UWF retinal mosaic. FOV: 200 degrees — 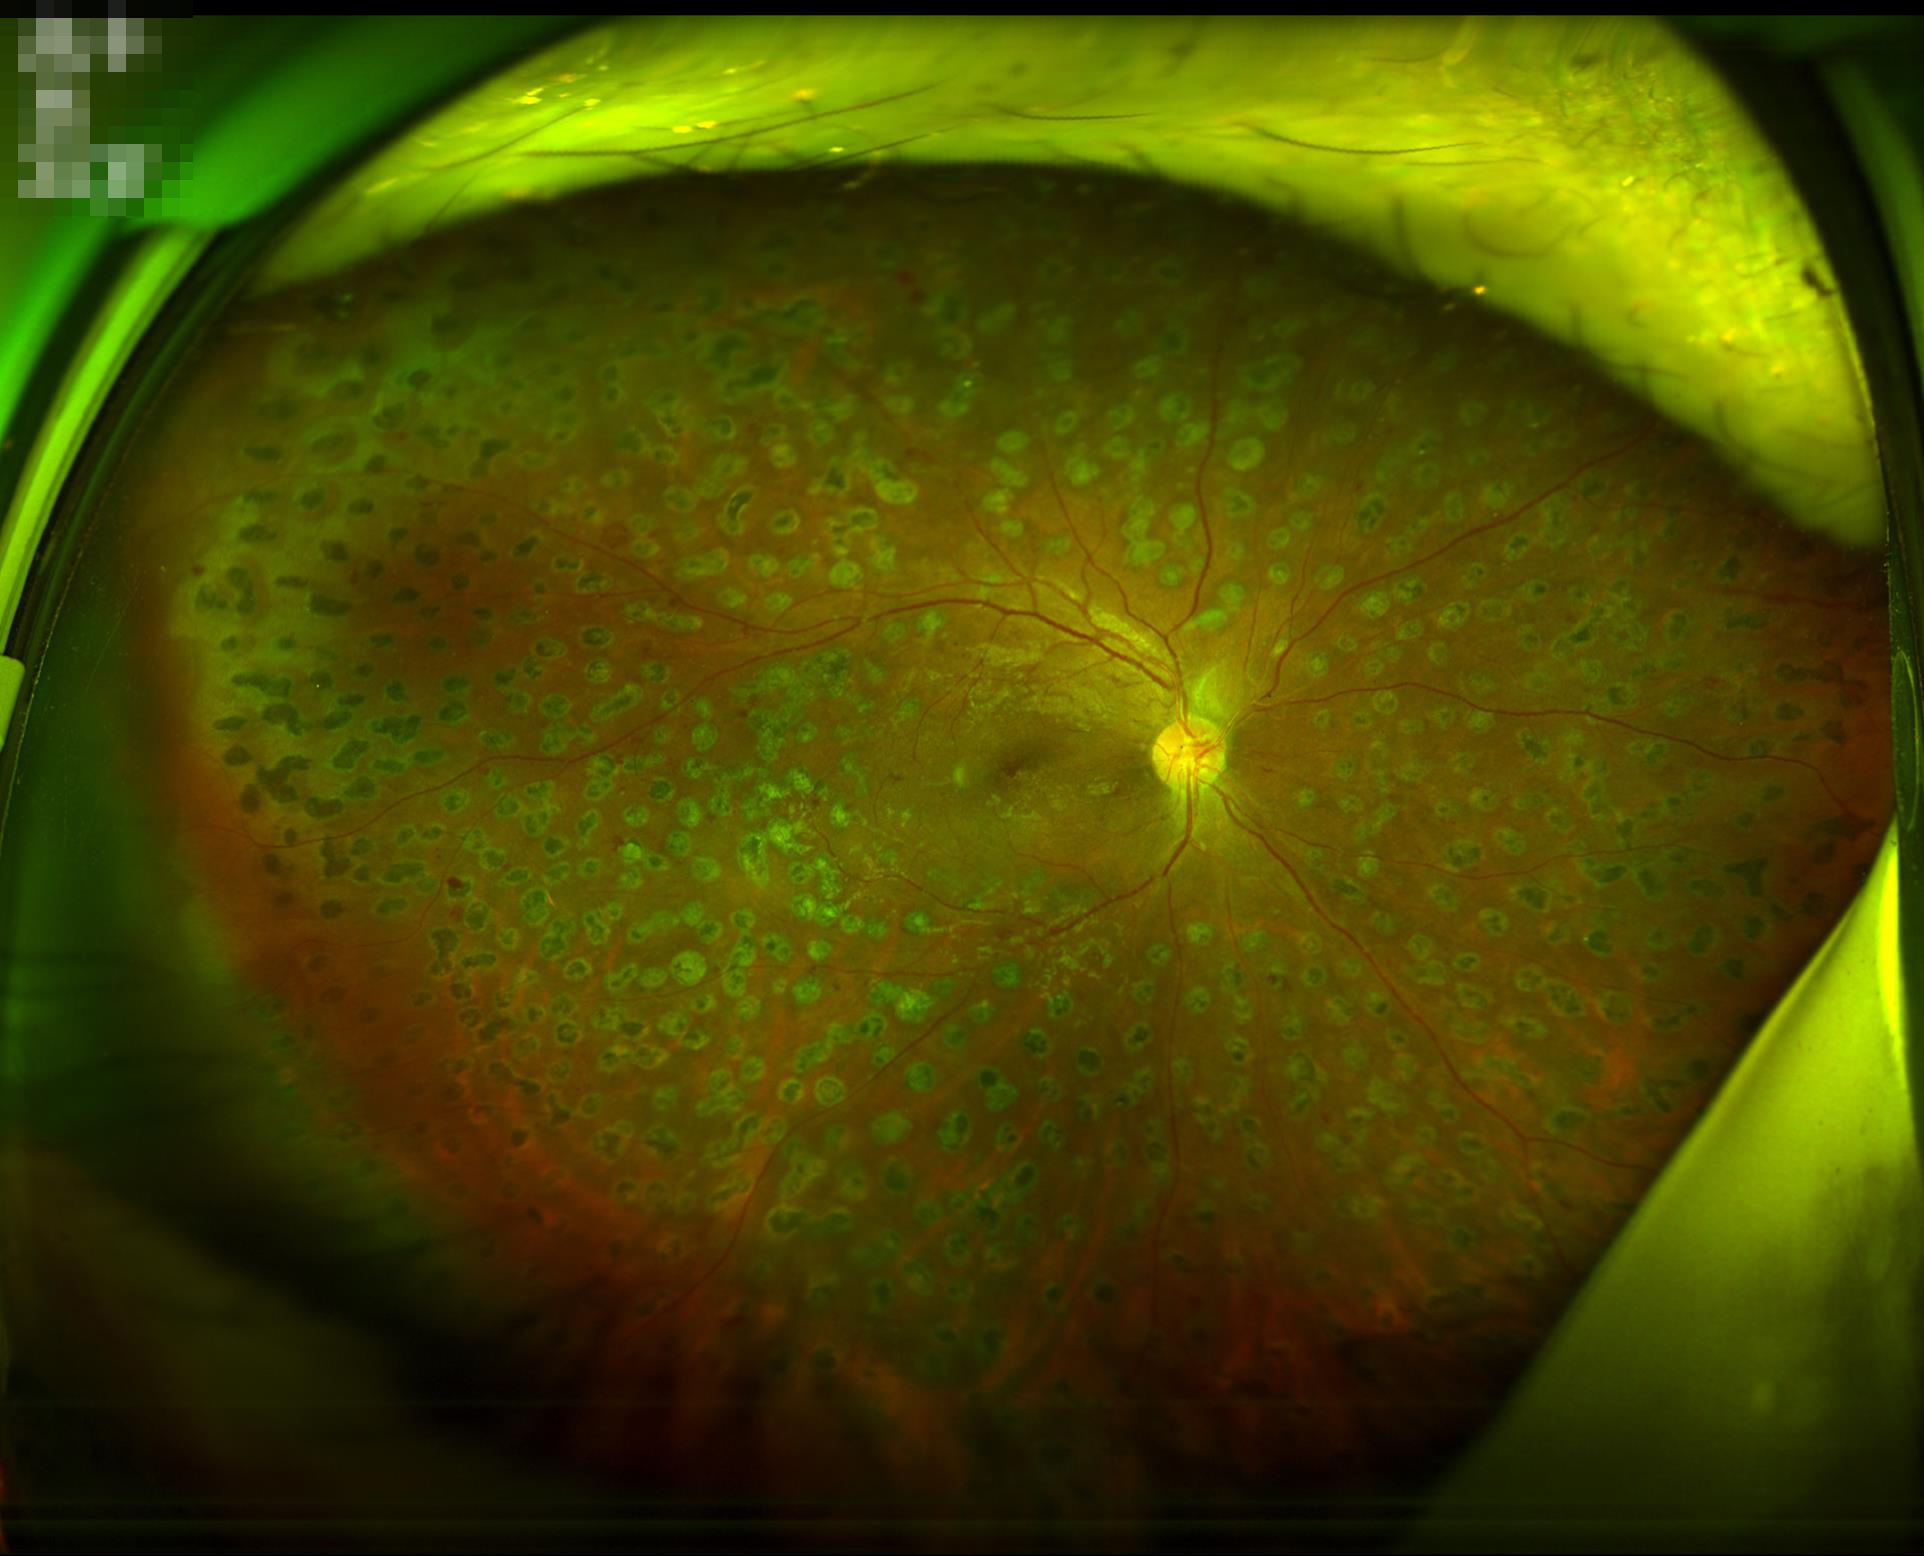 Acceptable image quality. Even illumination with no color cast. No noticeable blur.